2352x1568
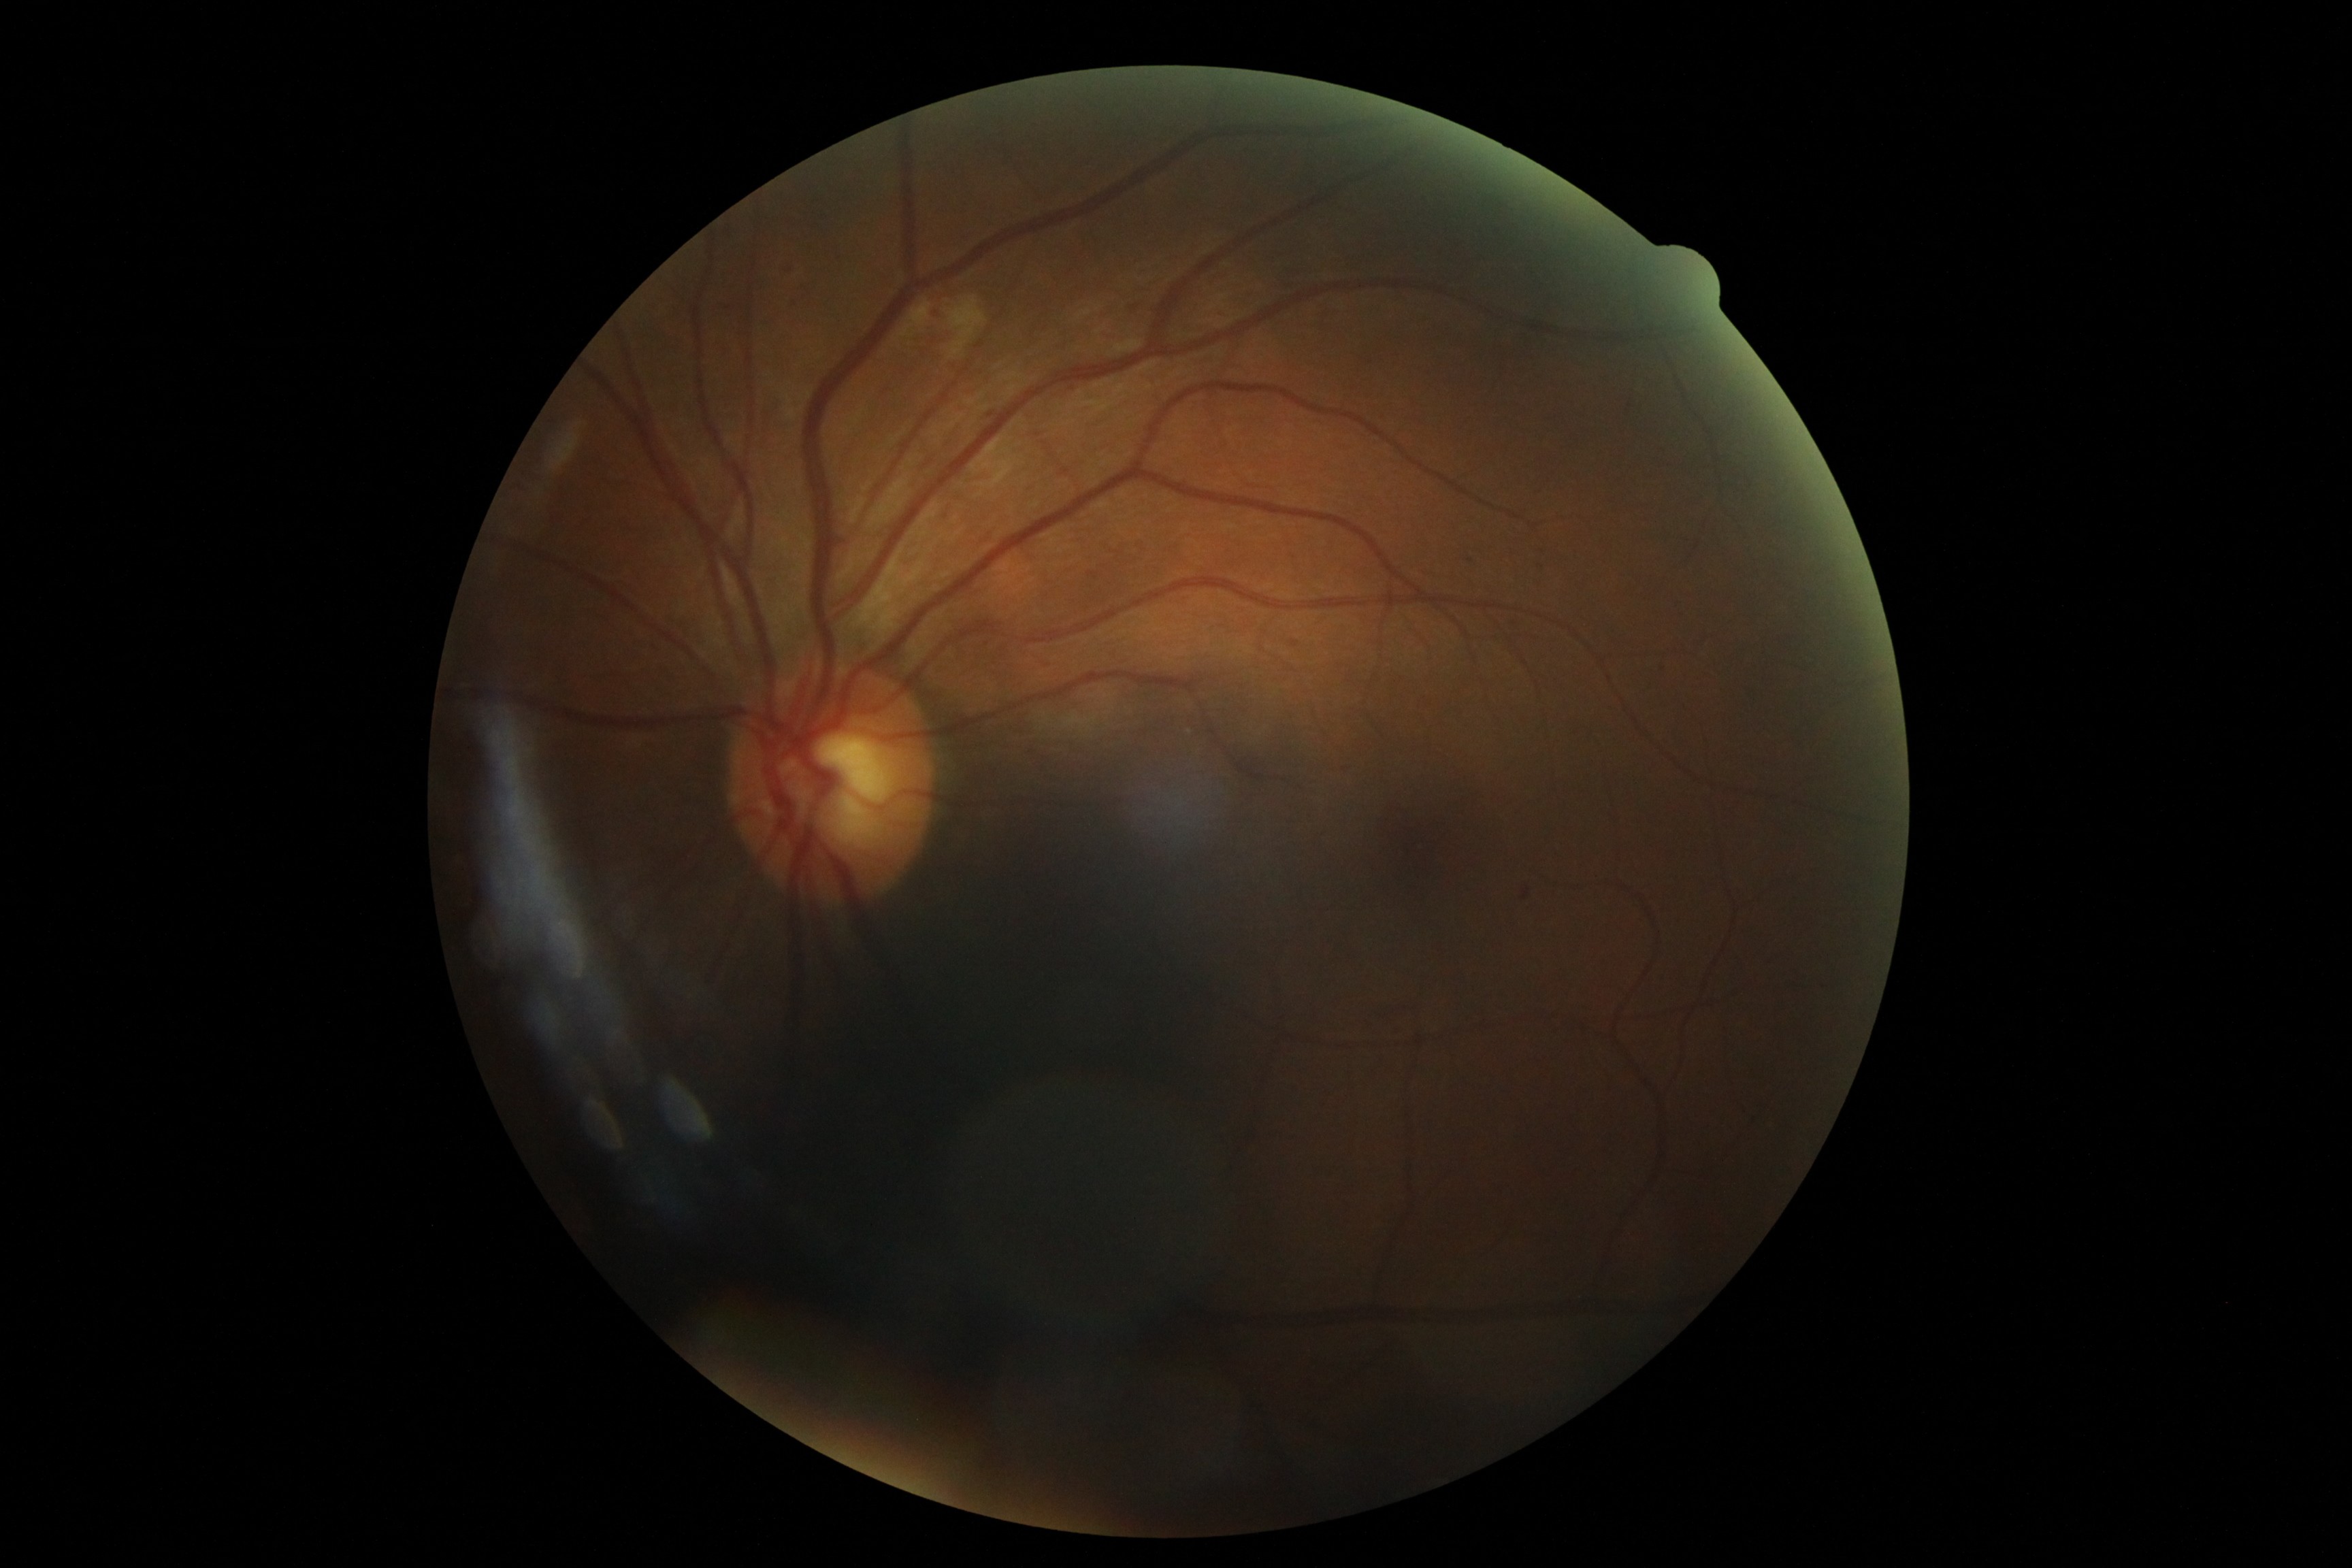

Annotations:
* diabetic retinopathy: grade 2 (moderate NPDR) — more than just microaneurysms but less than severe NPDR